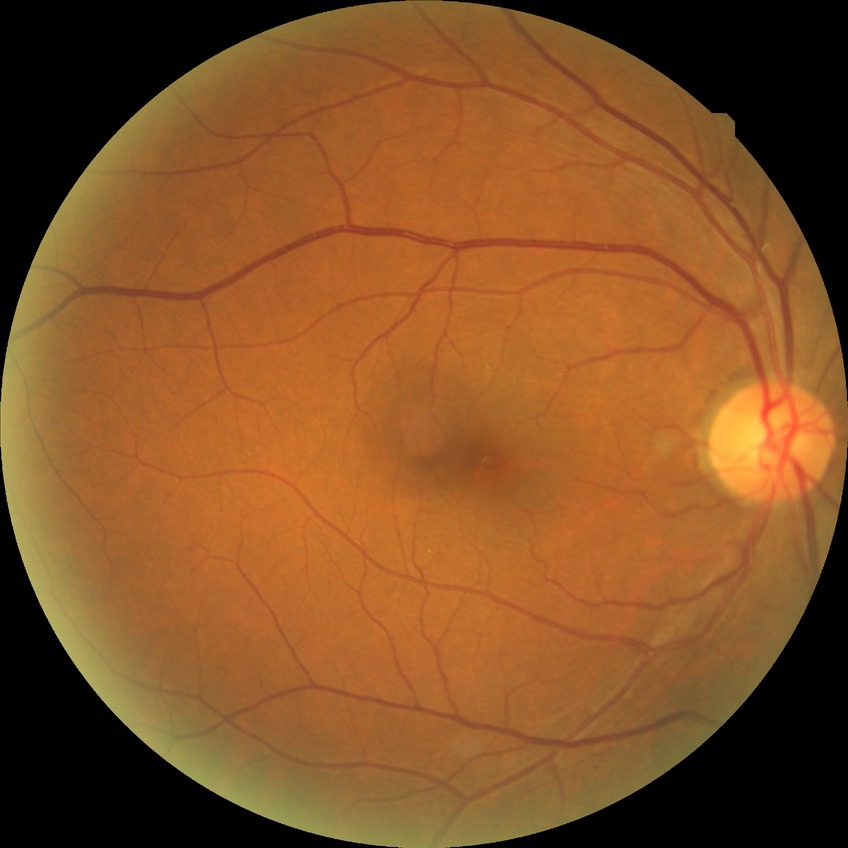
Retinopathy grade is no diabetic retinopathy.